Nonmydriatic — 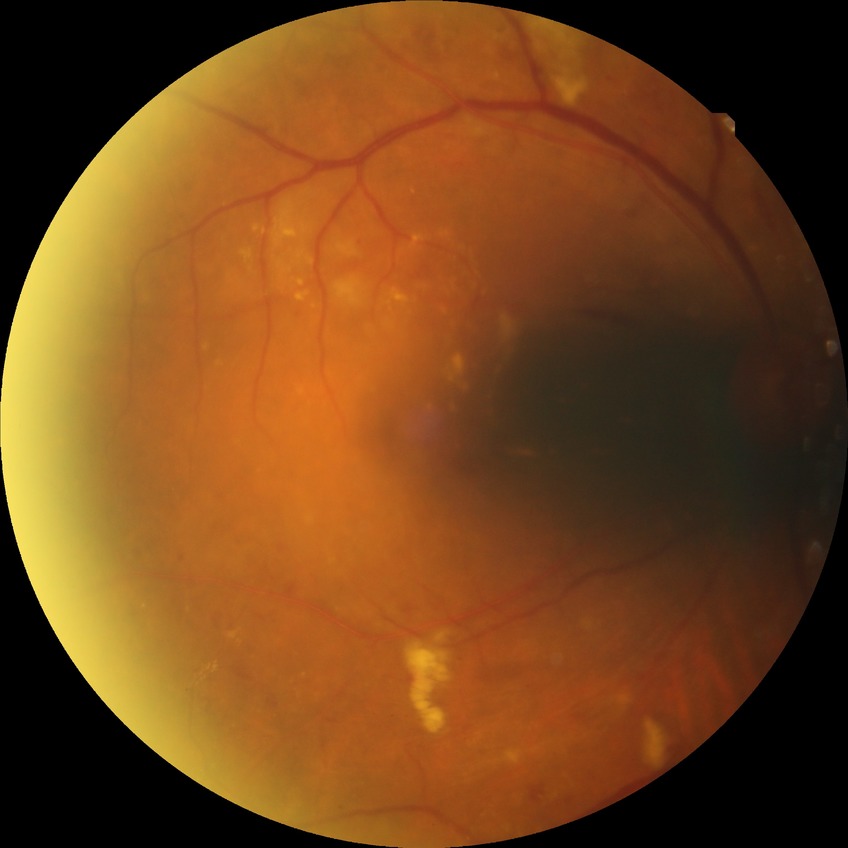 Diabetic retinopathy severity: pre-proliferative diabetic retinopathy. The retinopathy is classified as non-proliferative diabetic retinopathy.